2352x1568px. 45-degree field of view:
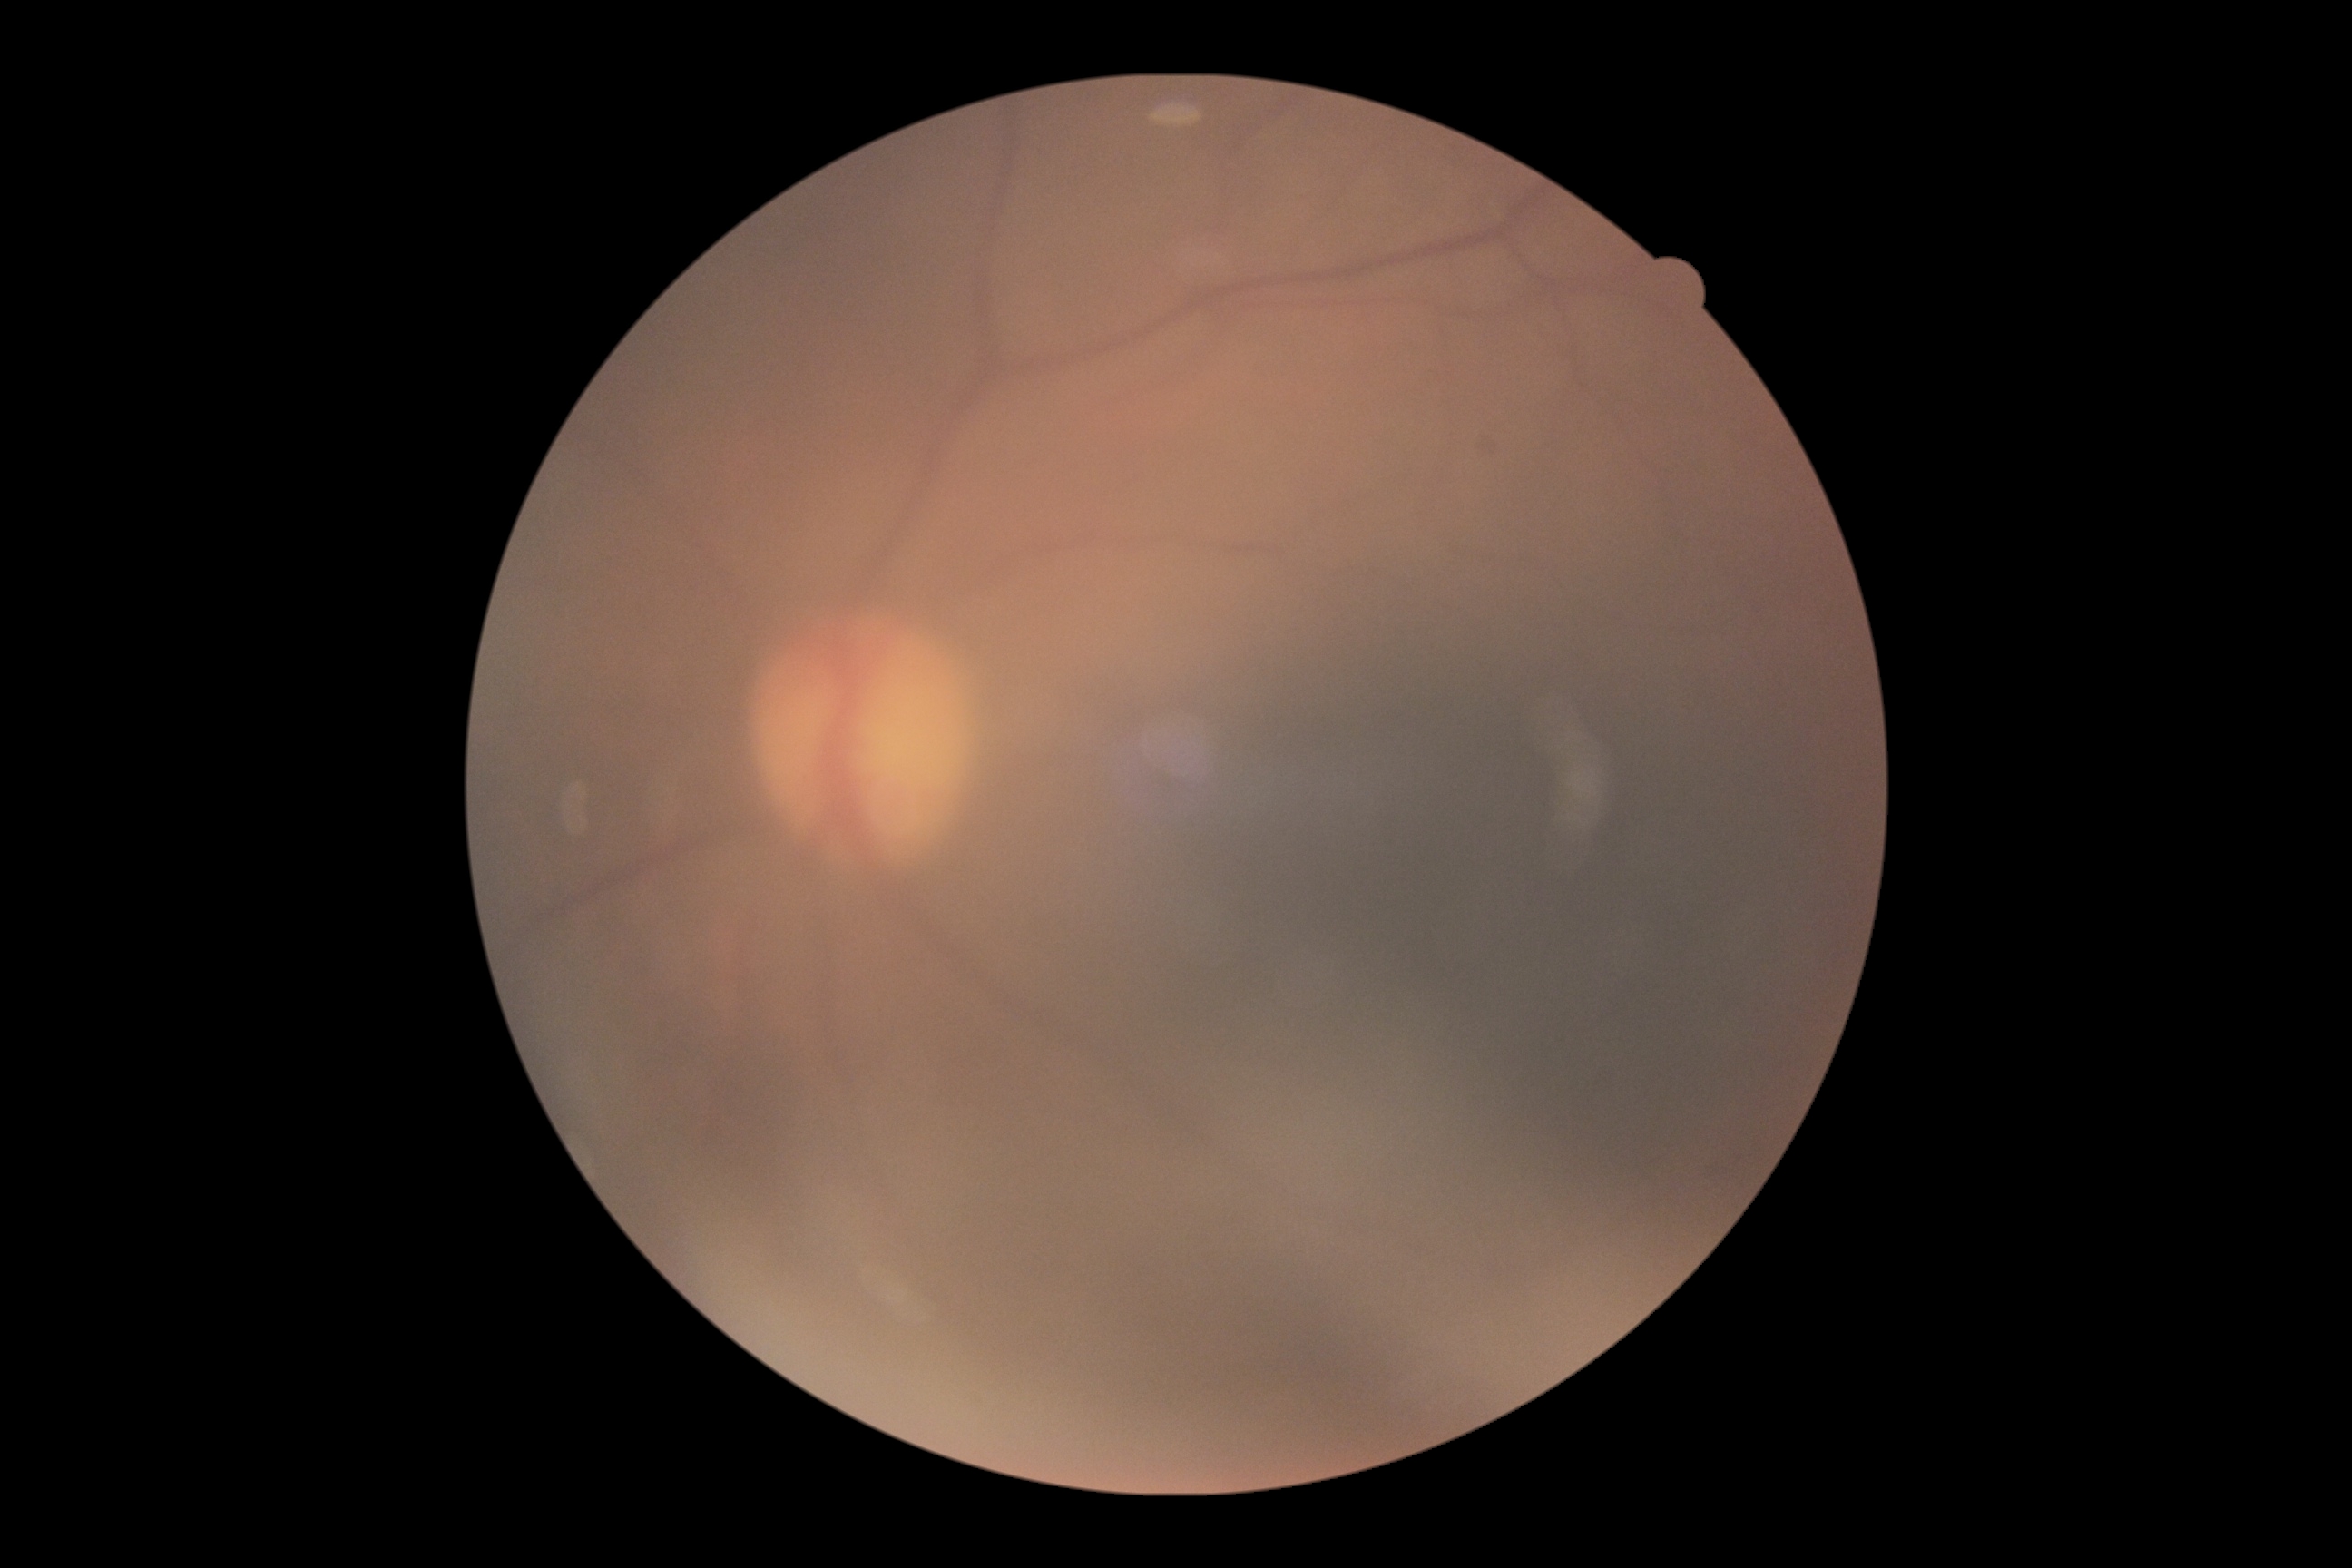
• diabetic retinopathy — ungradable due to poor image quality
• image quality — too poor for DR grading